Color fundus image. 45-degree field of view: 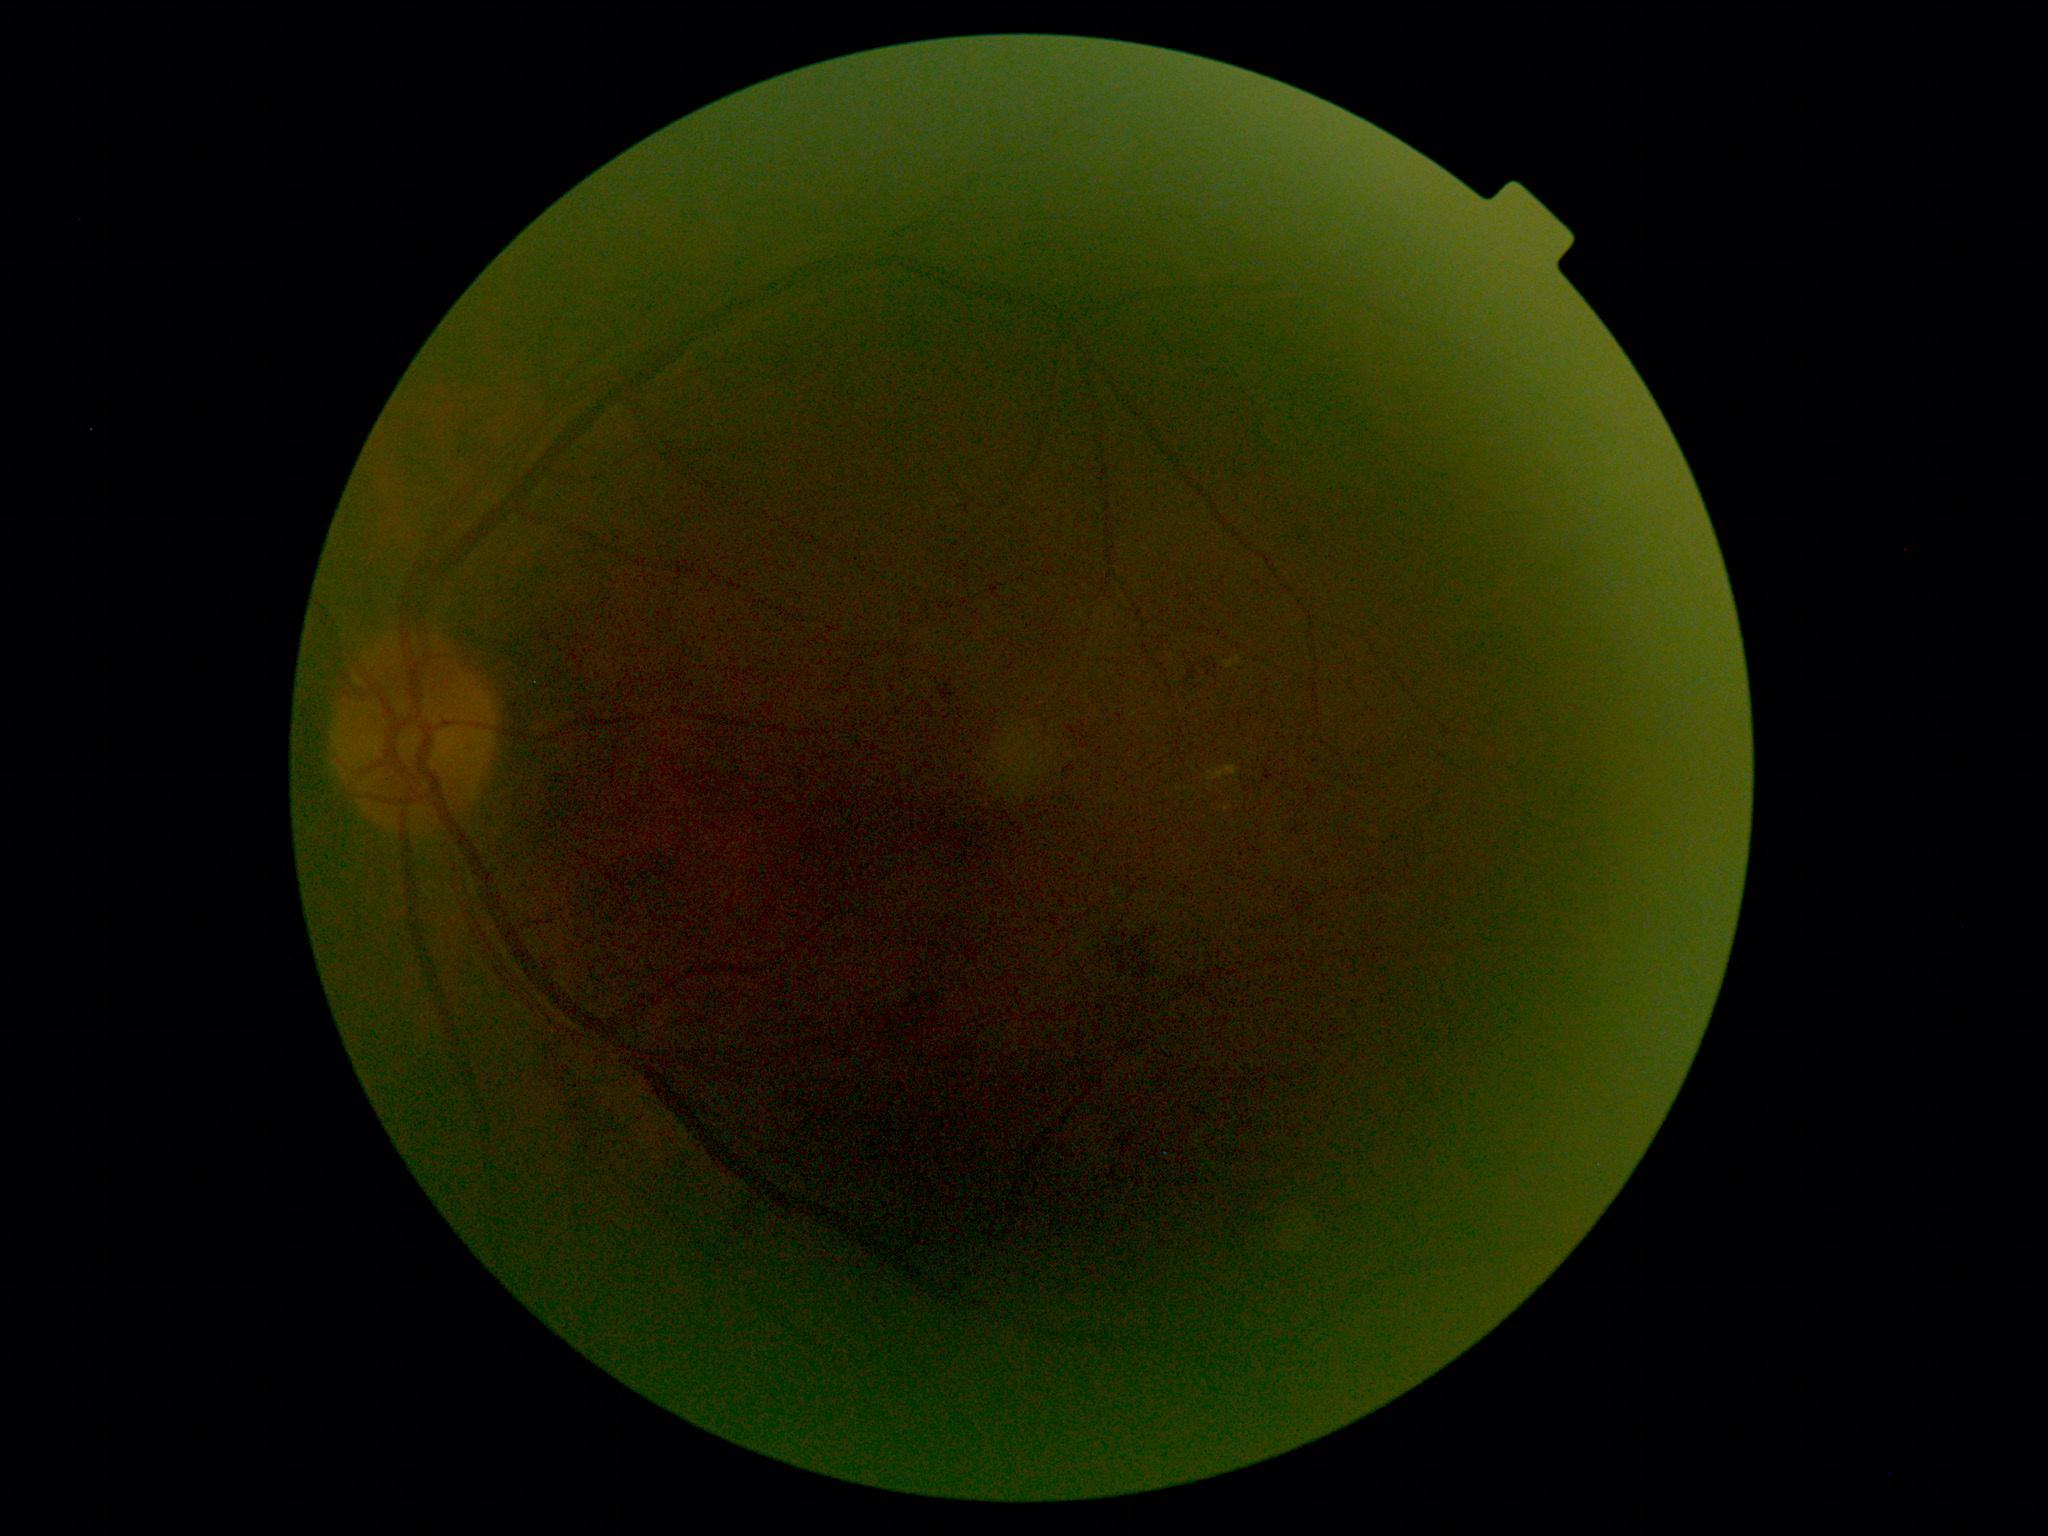
Retinopathy: grade 2 (moderate NPDR).